Diabetic retinopathy graded by the modified Davis classification
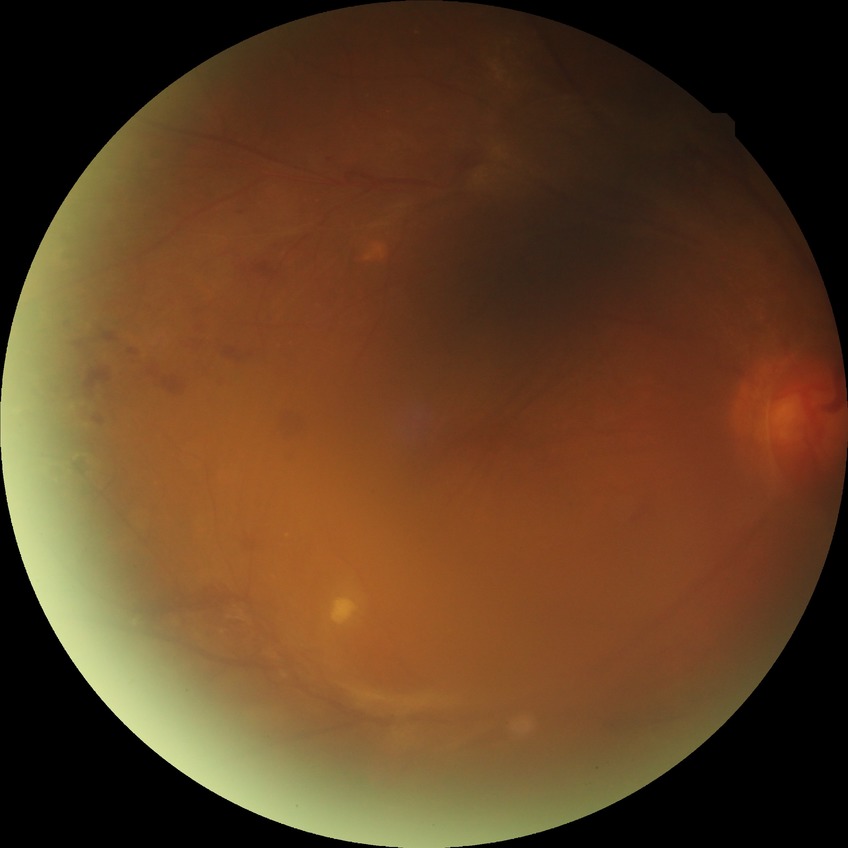
Diabetic retinopathy (DR) is PDR (proliferative diabetic retinopathy).